512 x 512 pixels, color fundus image:
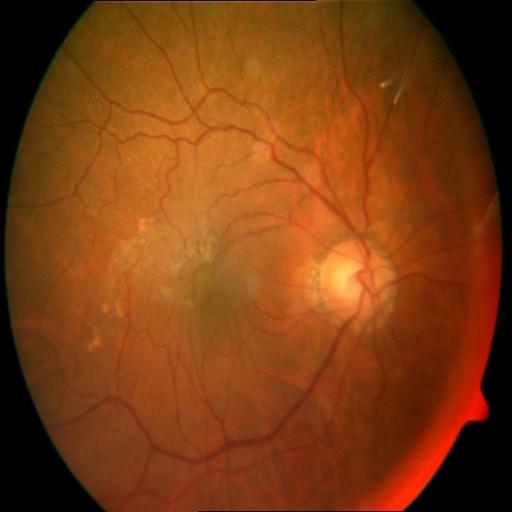

Demonstrates retinal traction & age-related macular degeneration.